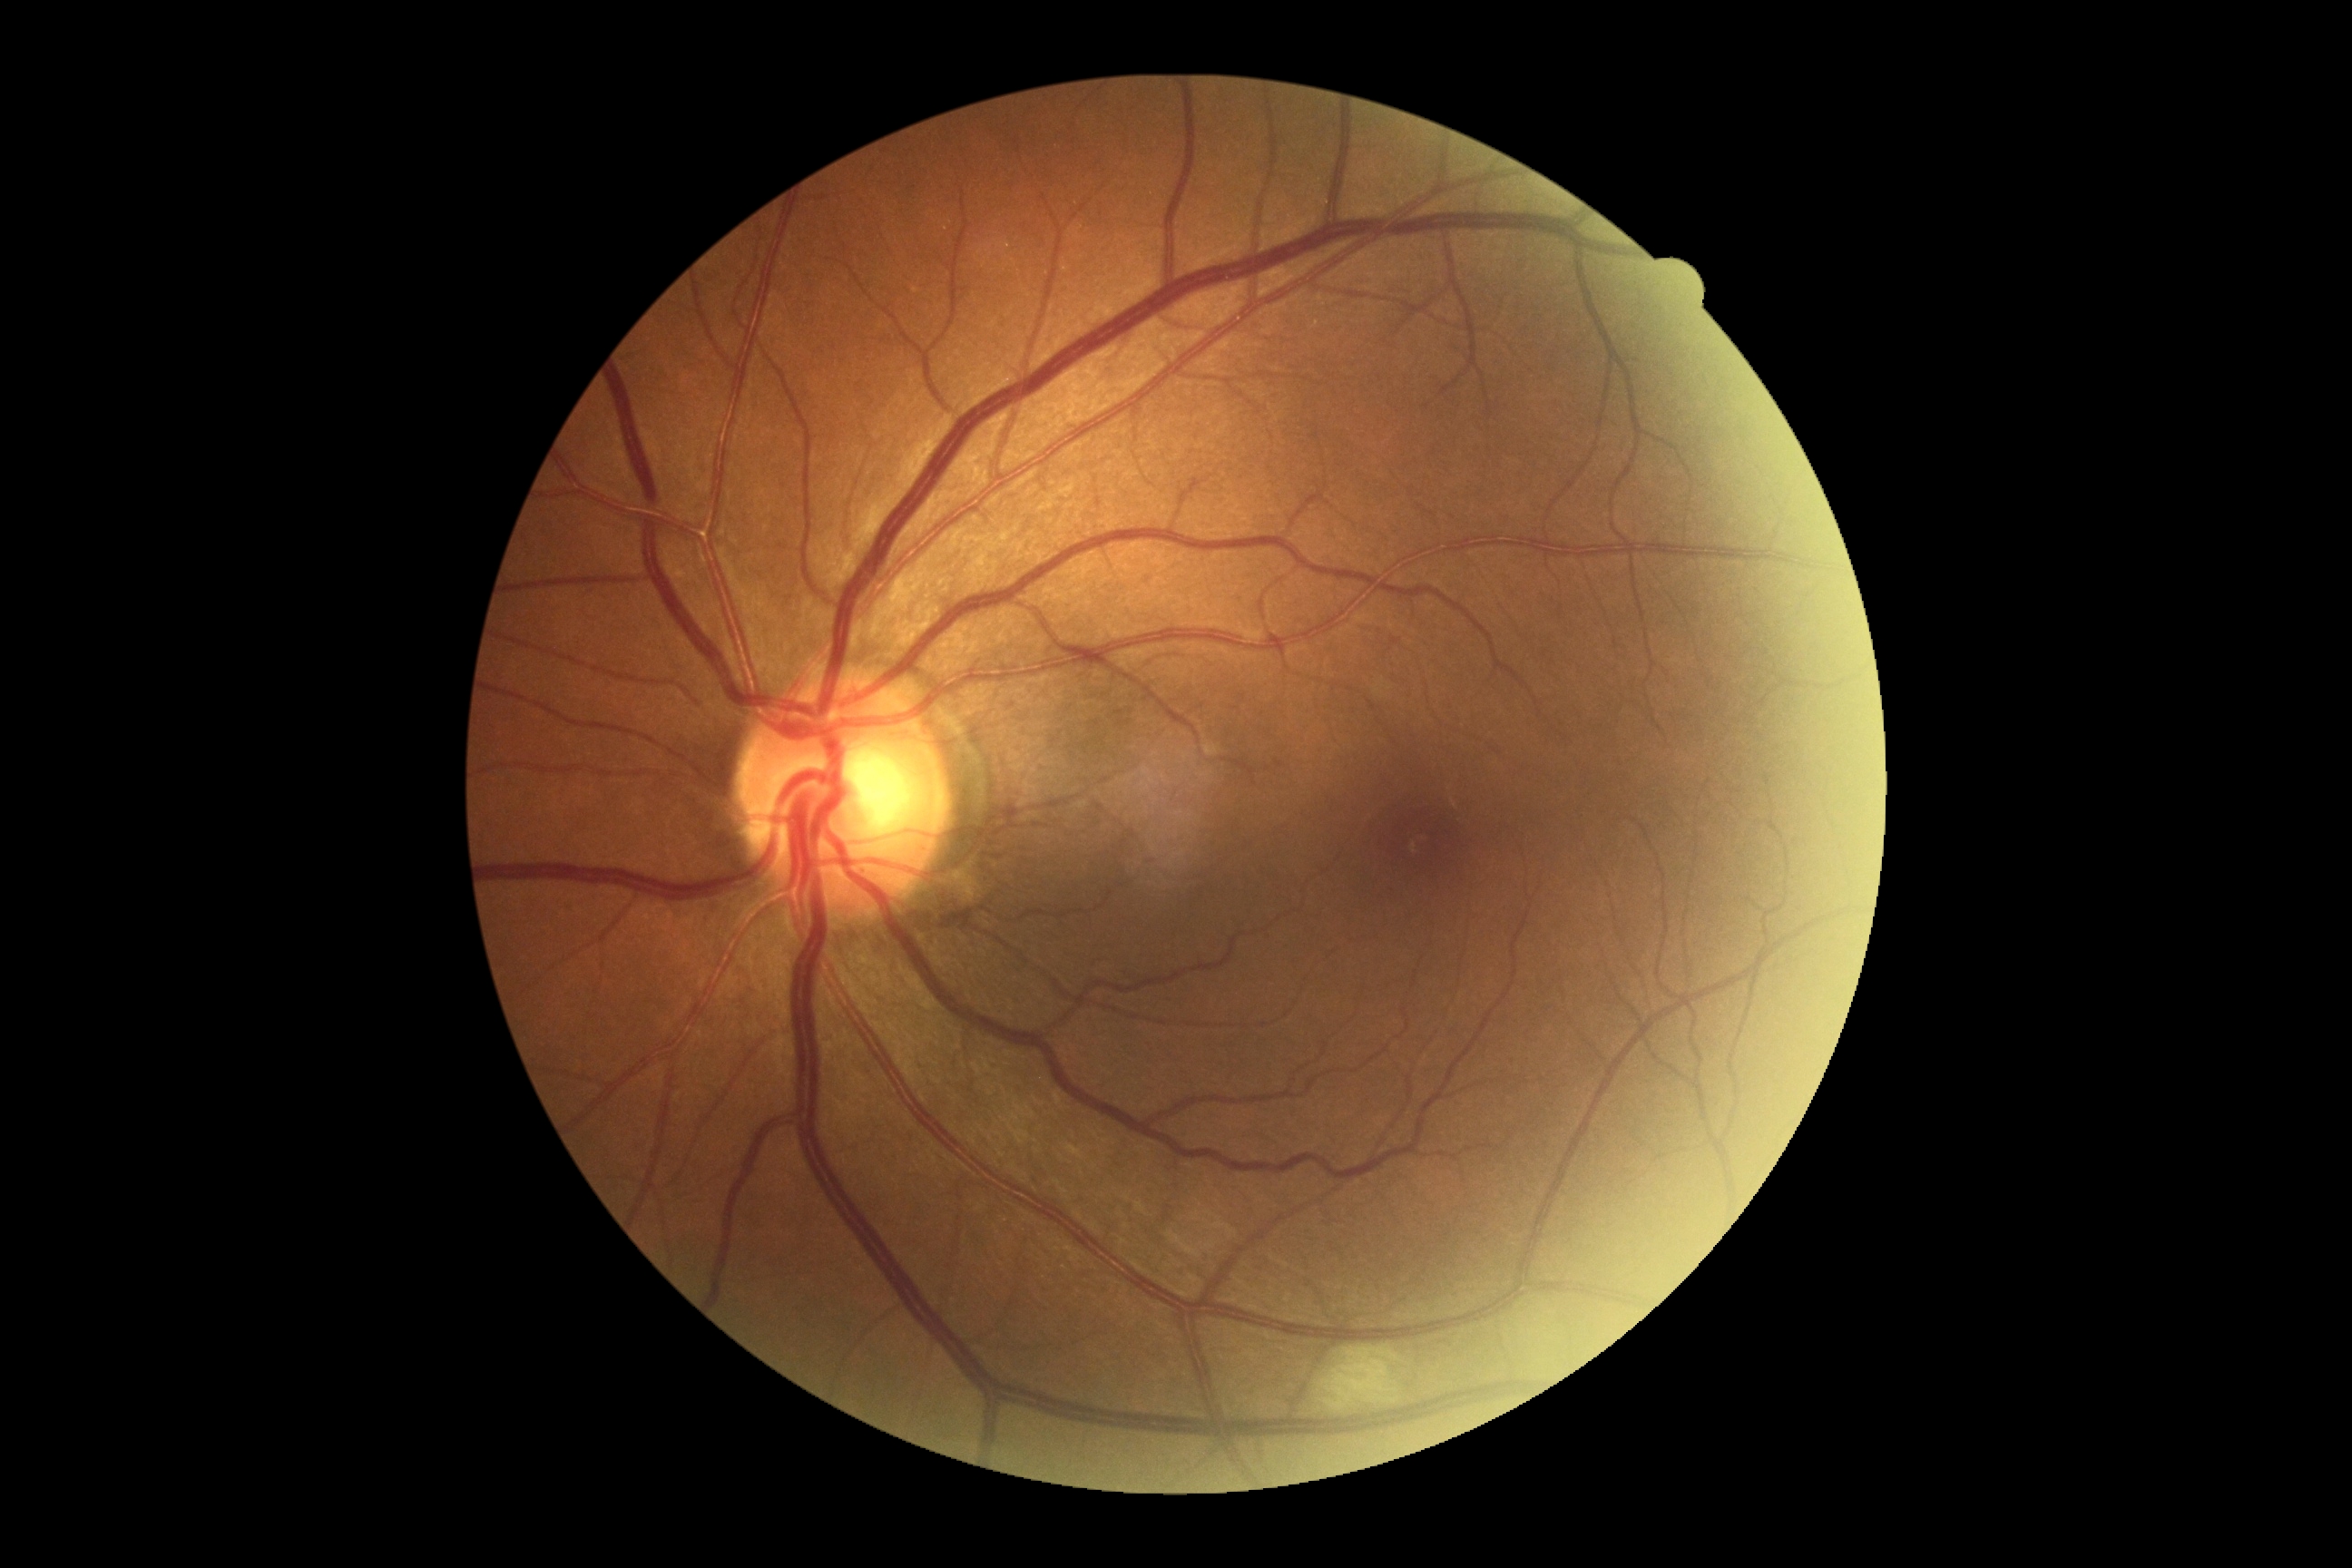
diabetic retinopathy grade = moderate NPDR (2)